Fundus photo · without pupil dilation
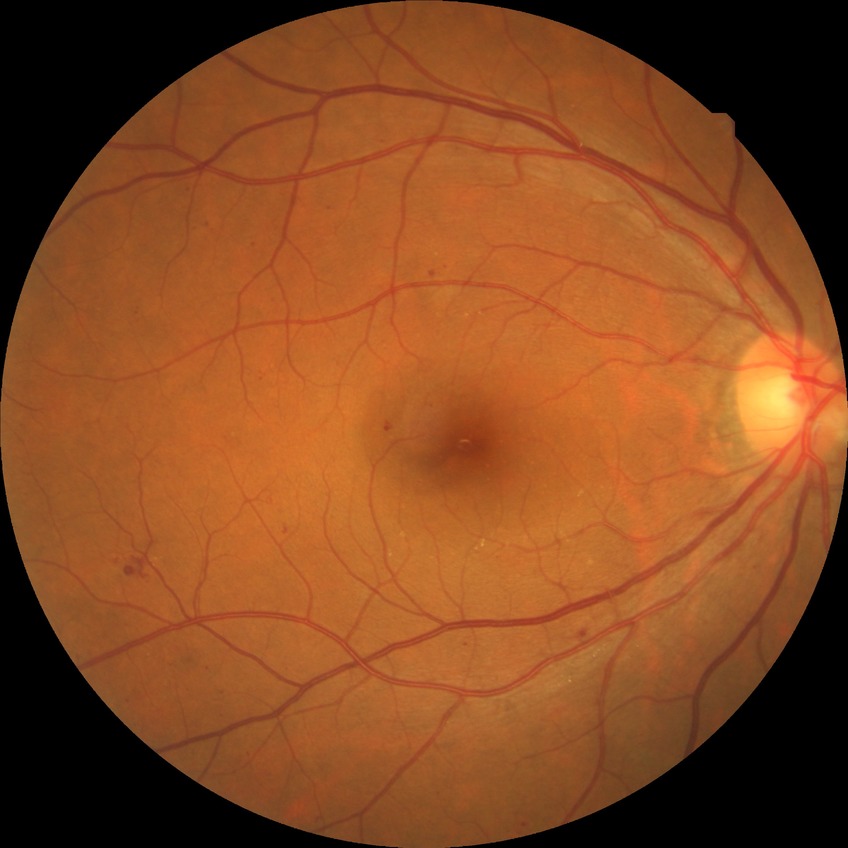 Diabetic retinopathy (DR) is SDR (simple diabetic retinopathy).